Optic disc-centered crop; non-mydriatic acquisition — 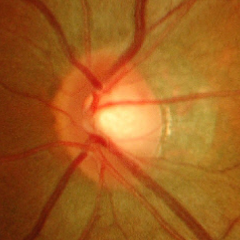

The image shows advanced glaucomatous optic neuropathy.